Wide-field fundus photograph of an infant; image size 1240x1240.
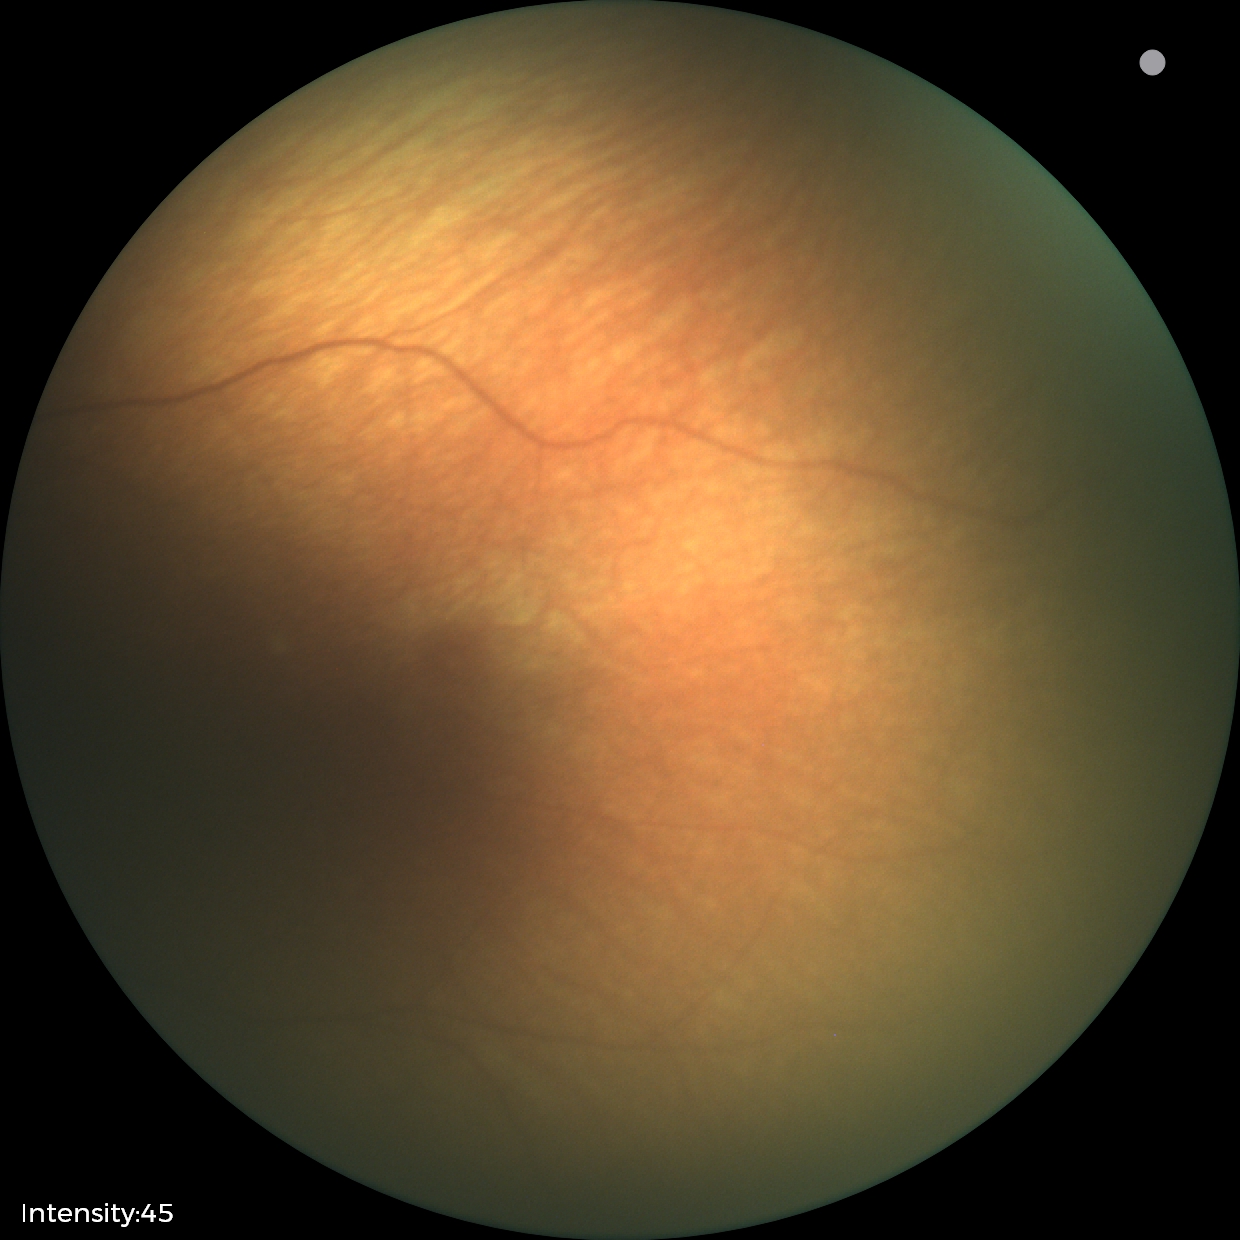 Assessment: physiological appearance with no retinal pathology.